Image size 2212x1659 · retinal fundus photograph — 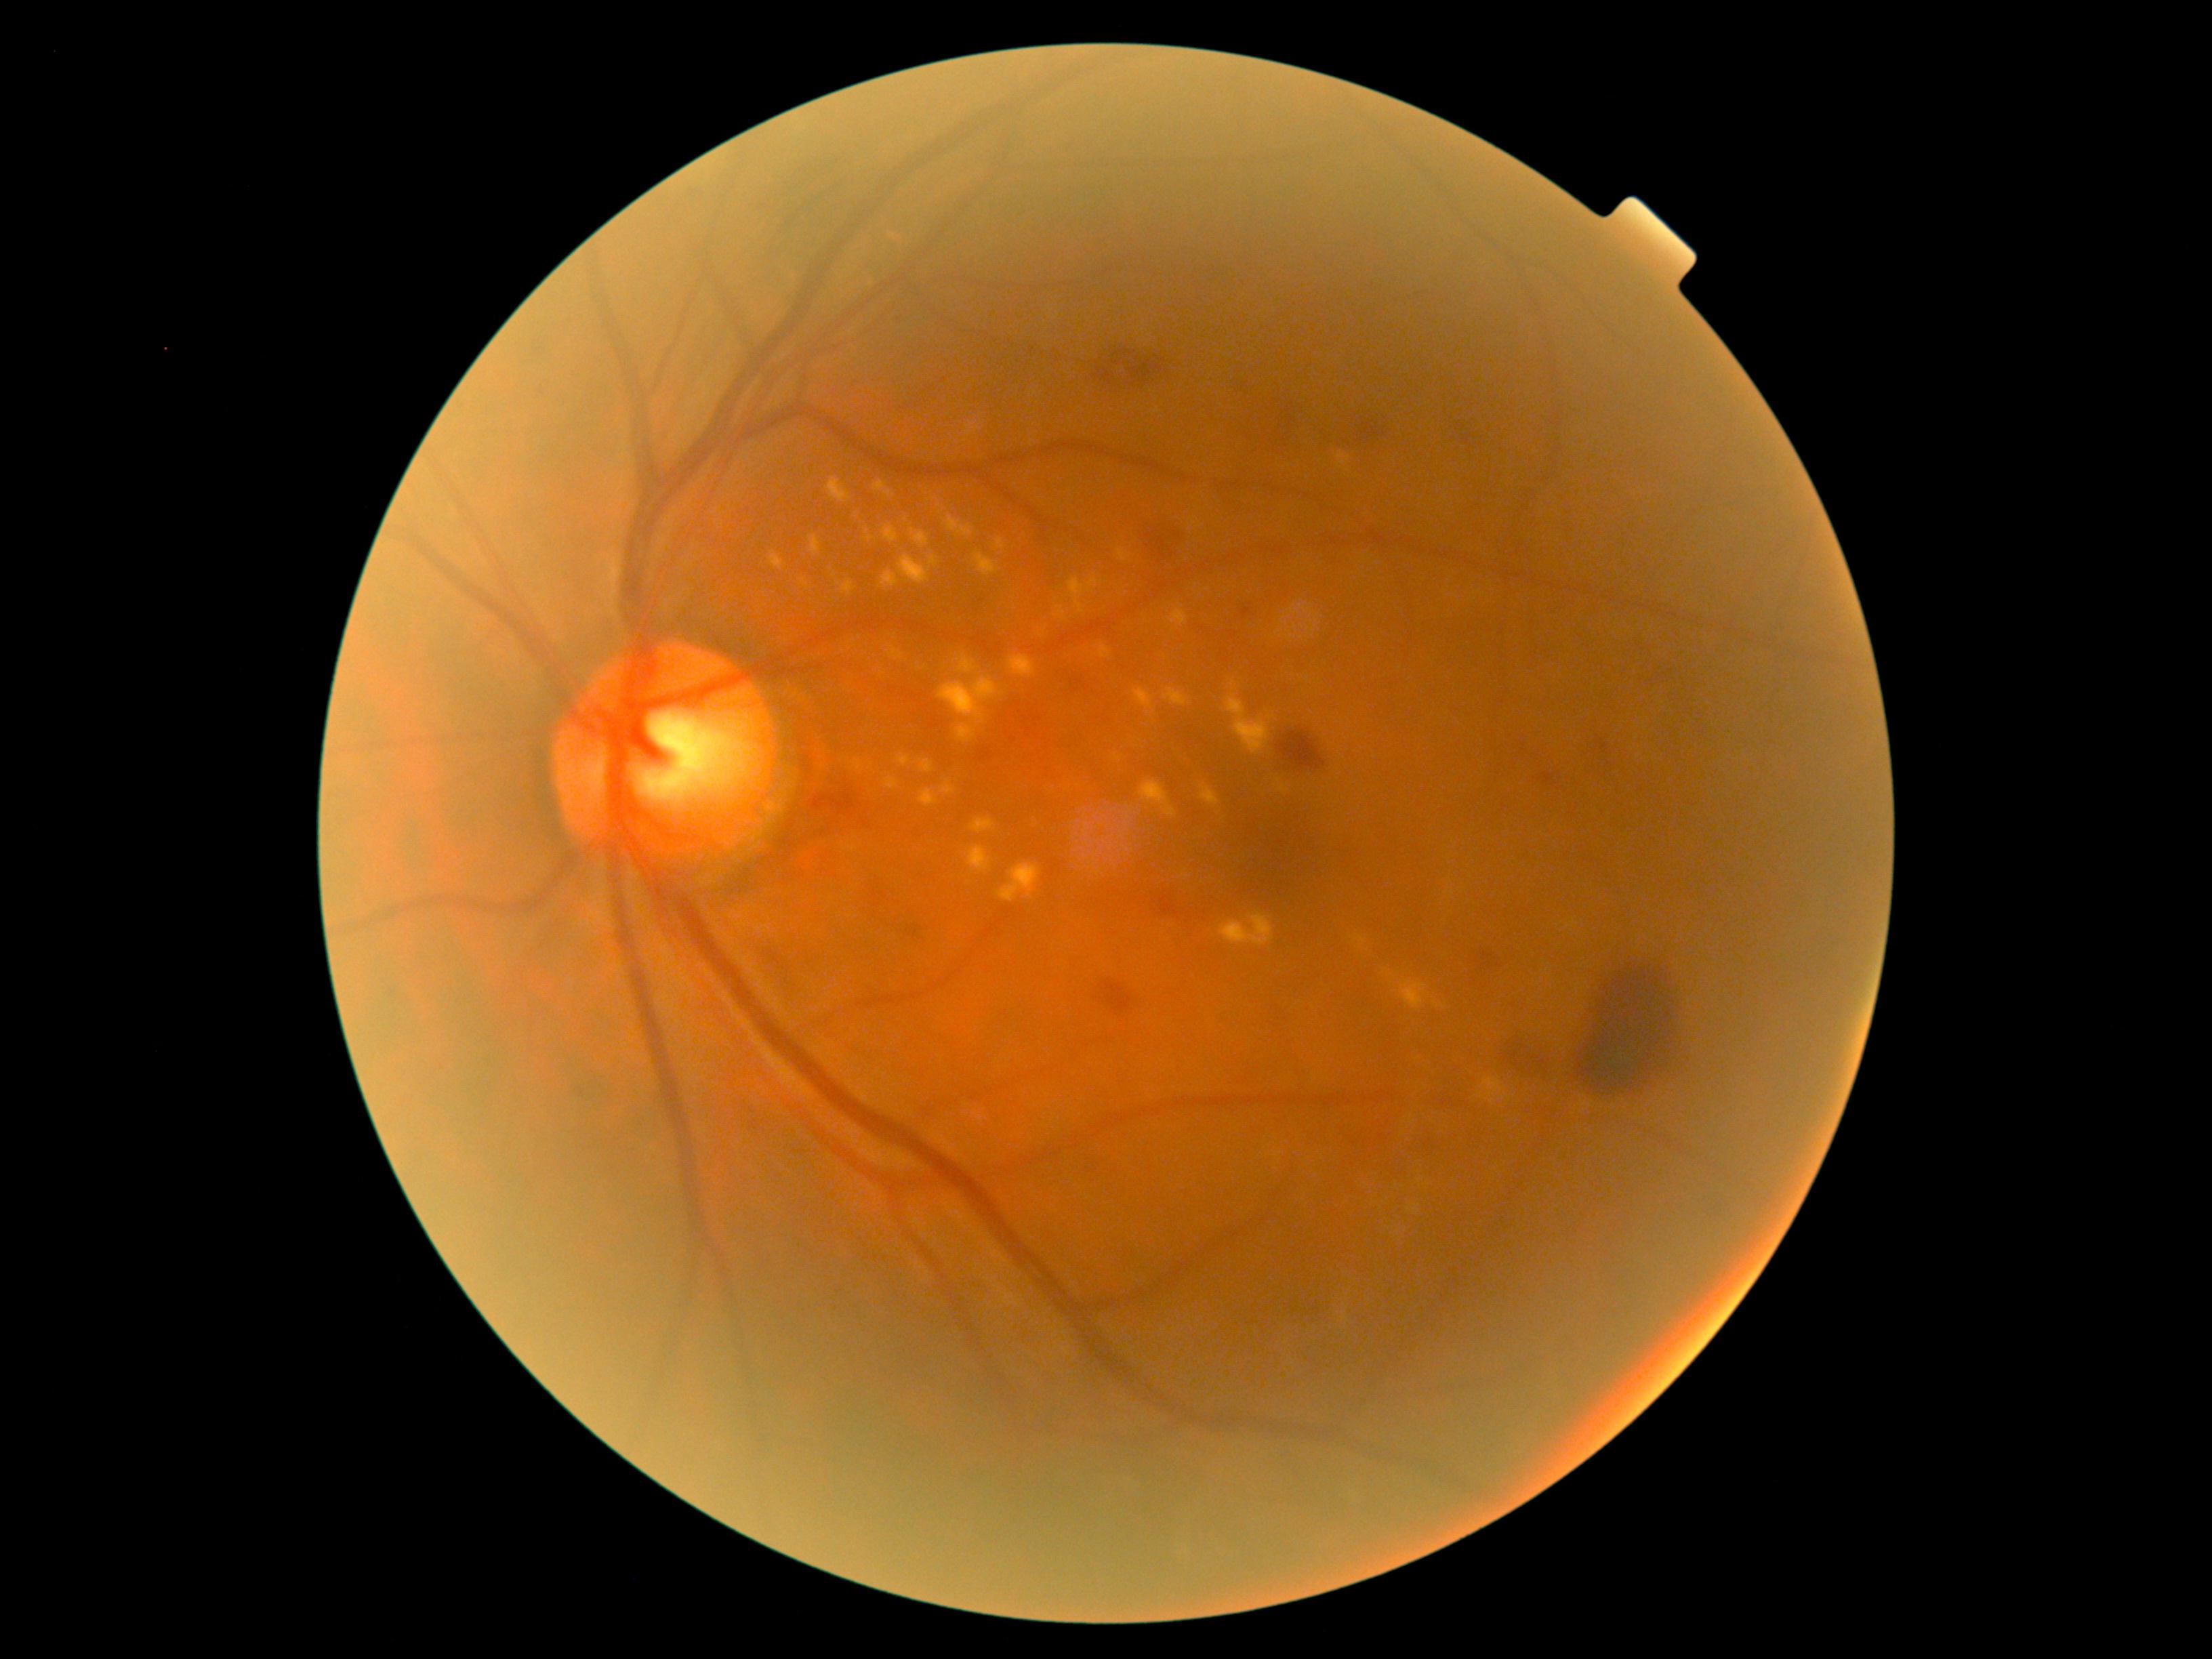

Diabetic retinopathy (DR): grade 2 — more than just microaneurysms but less than severe NPDR
A subset of detected lesions:
- hard exudates (EXs) (subset): [left=833, top=578, right=857, bottom=593] | [left=975, top=552, right=1000, bottom=577] | [left=1139, top=781, right=1177, bottom=817] | [left=1099, top=644, right=1112, bottom=659] | [left=1134, top=689, right=1154, bottom=708] | [left=887, top=517, right=905, bottom=543] | [left=1189, top=518, right=1196, bottom=527] | [left=947, top=653, right=1000, bottom=696] | [left=874, top=476, right=888, bottom=498] | [left=1483, top=1078, right=1504, bottom=1105] | [left=941, top=776, right=958, bottom=791] | [left=1433, top=1001, right=1447, bottom=1009] | [left=1069, top=578, right=1099, bottom=613] | [left=855, top=506, right=871, bottom=547] | [left=880, top=776, right=903, bottom=783]
- Smaller EXs around pt(1233, 683)